Acquired on the Clarity RetCam 3. Infant wide-field retinal image — 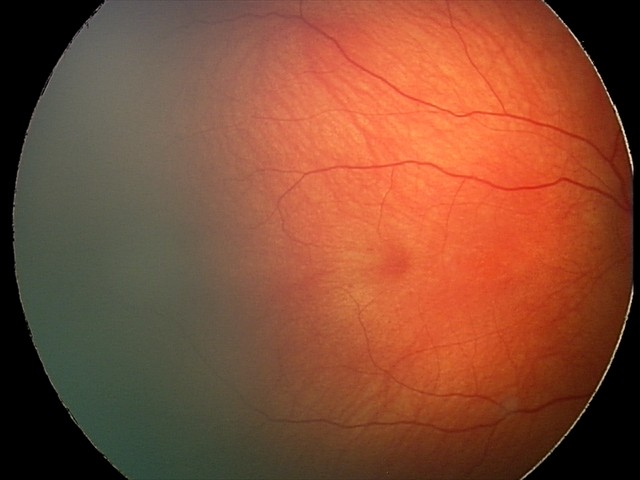

Screening series with retinal hemorrhages.